848 by 848 pixels. 45° field of view. Acquired with a NIDEK AFC-230 — 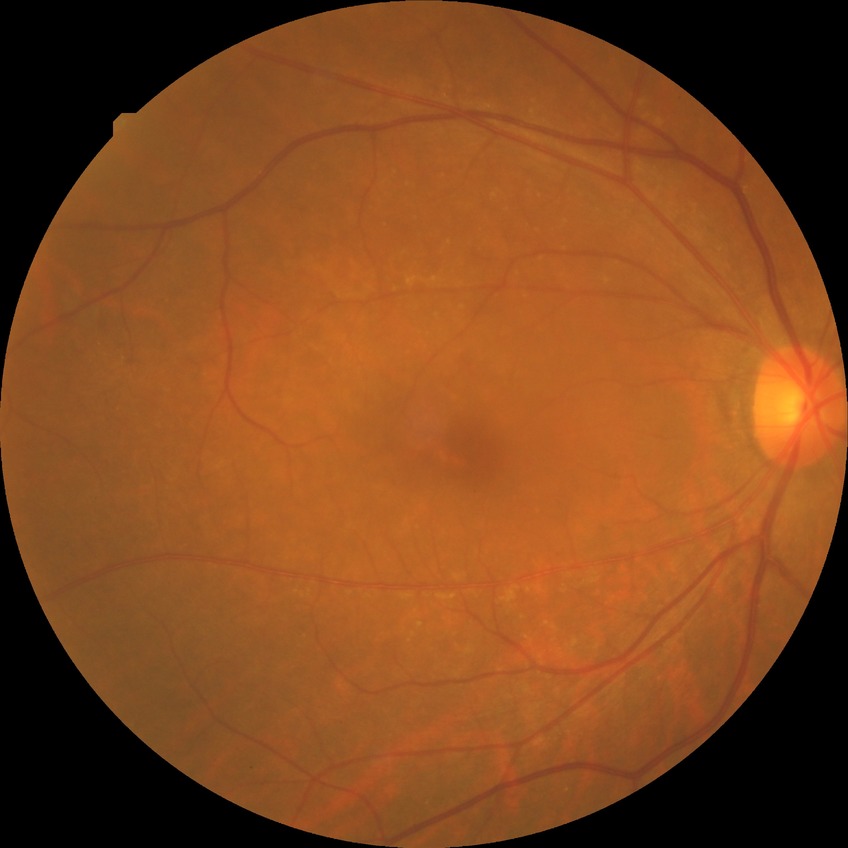

Diabetic retinopathy (DR) is no diabetic retinopathy (NDR).